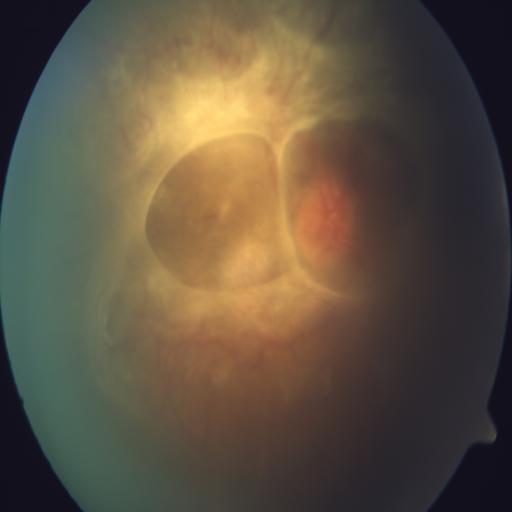
Pathology (2): cystoid macular edema (CME); retinal traction (RT).